Phoenix ICON wide-field infant fundus image
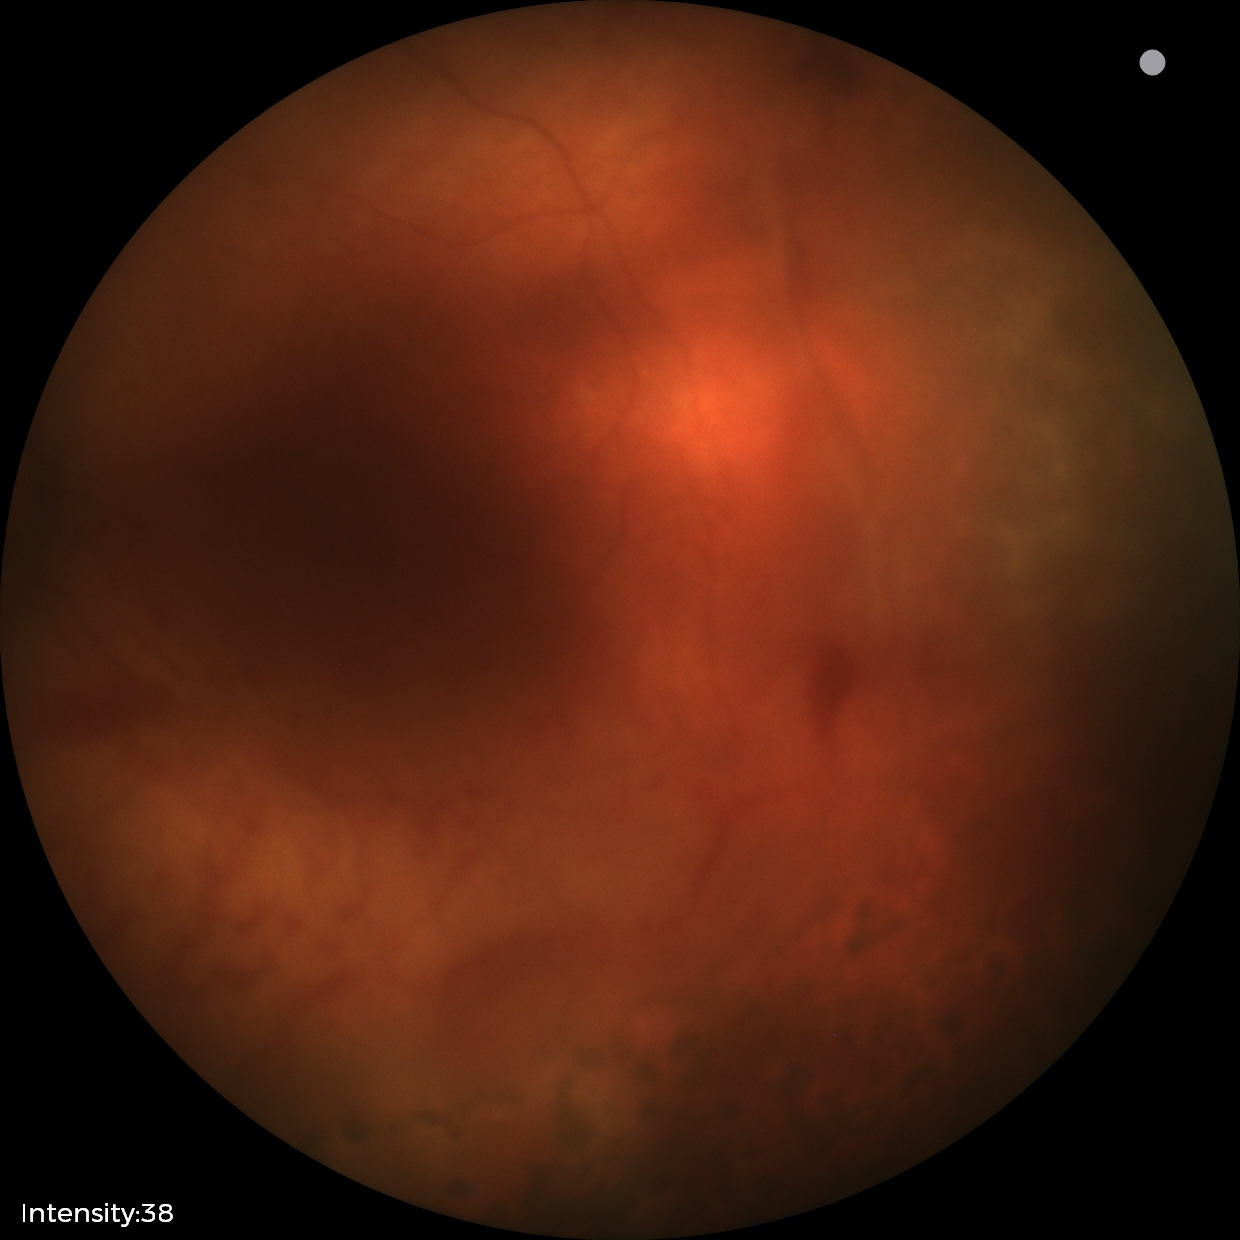

Diagnosis from this screening exam: status post retinopathy of prematurity.